45 degree fundus photograph:
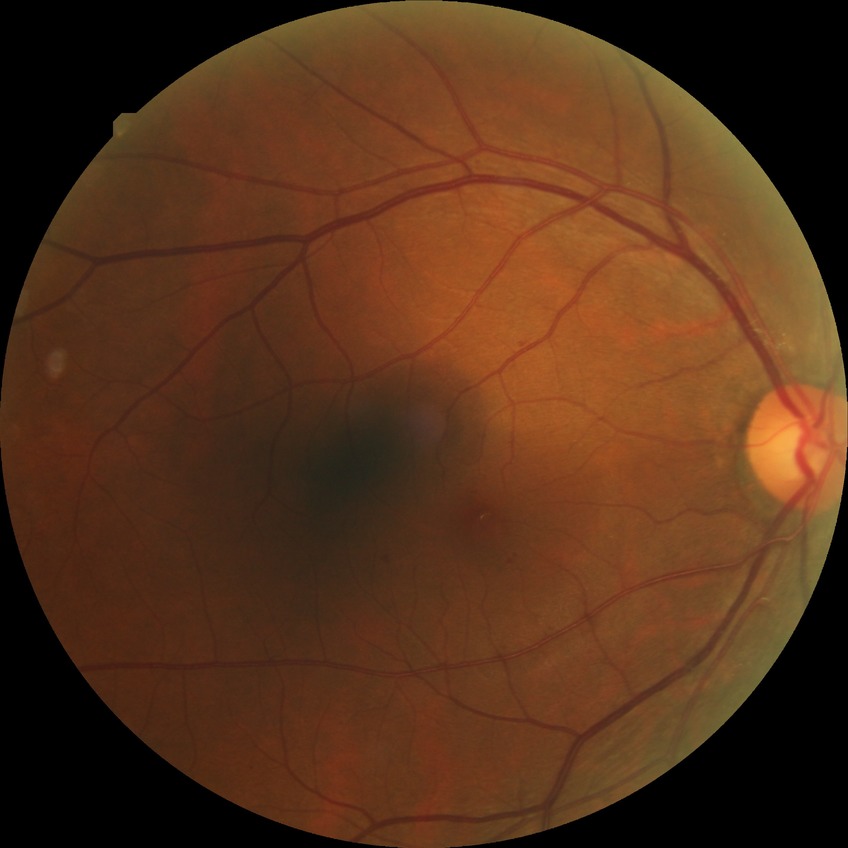

Diabetic retinopathy (DR) is simple diabetic retinopathy (SDR).